NIDEK AFC-230 fundus camera, nonmydriatic, 45° field of view, 848 by 848 pixels
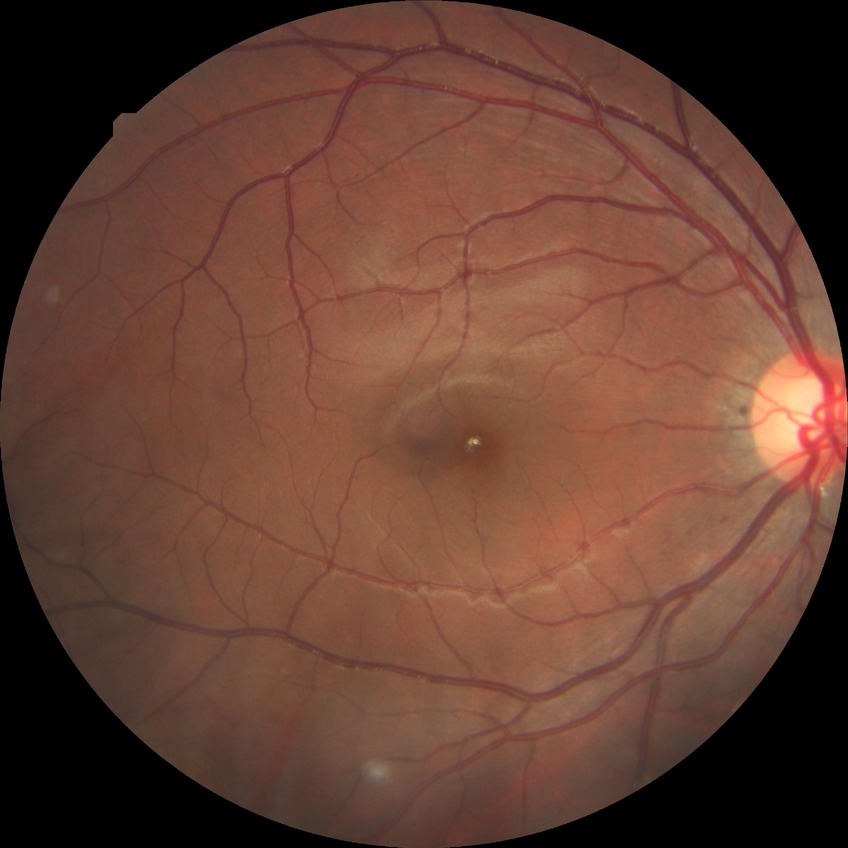 No signs of diabetic retinopathy.
DR severity is NDR.